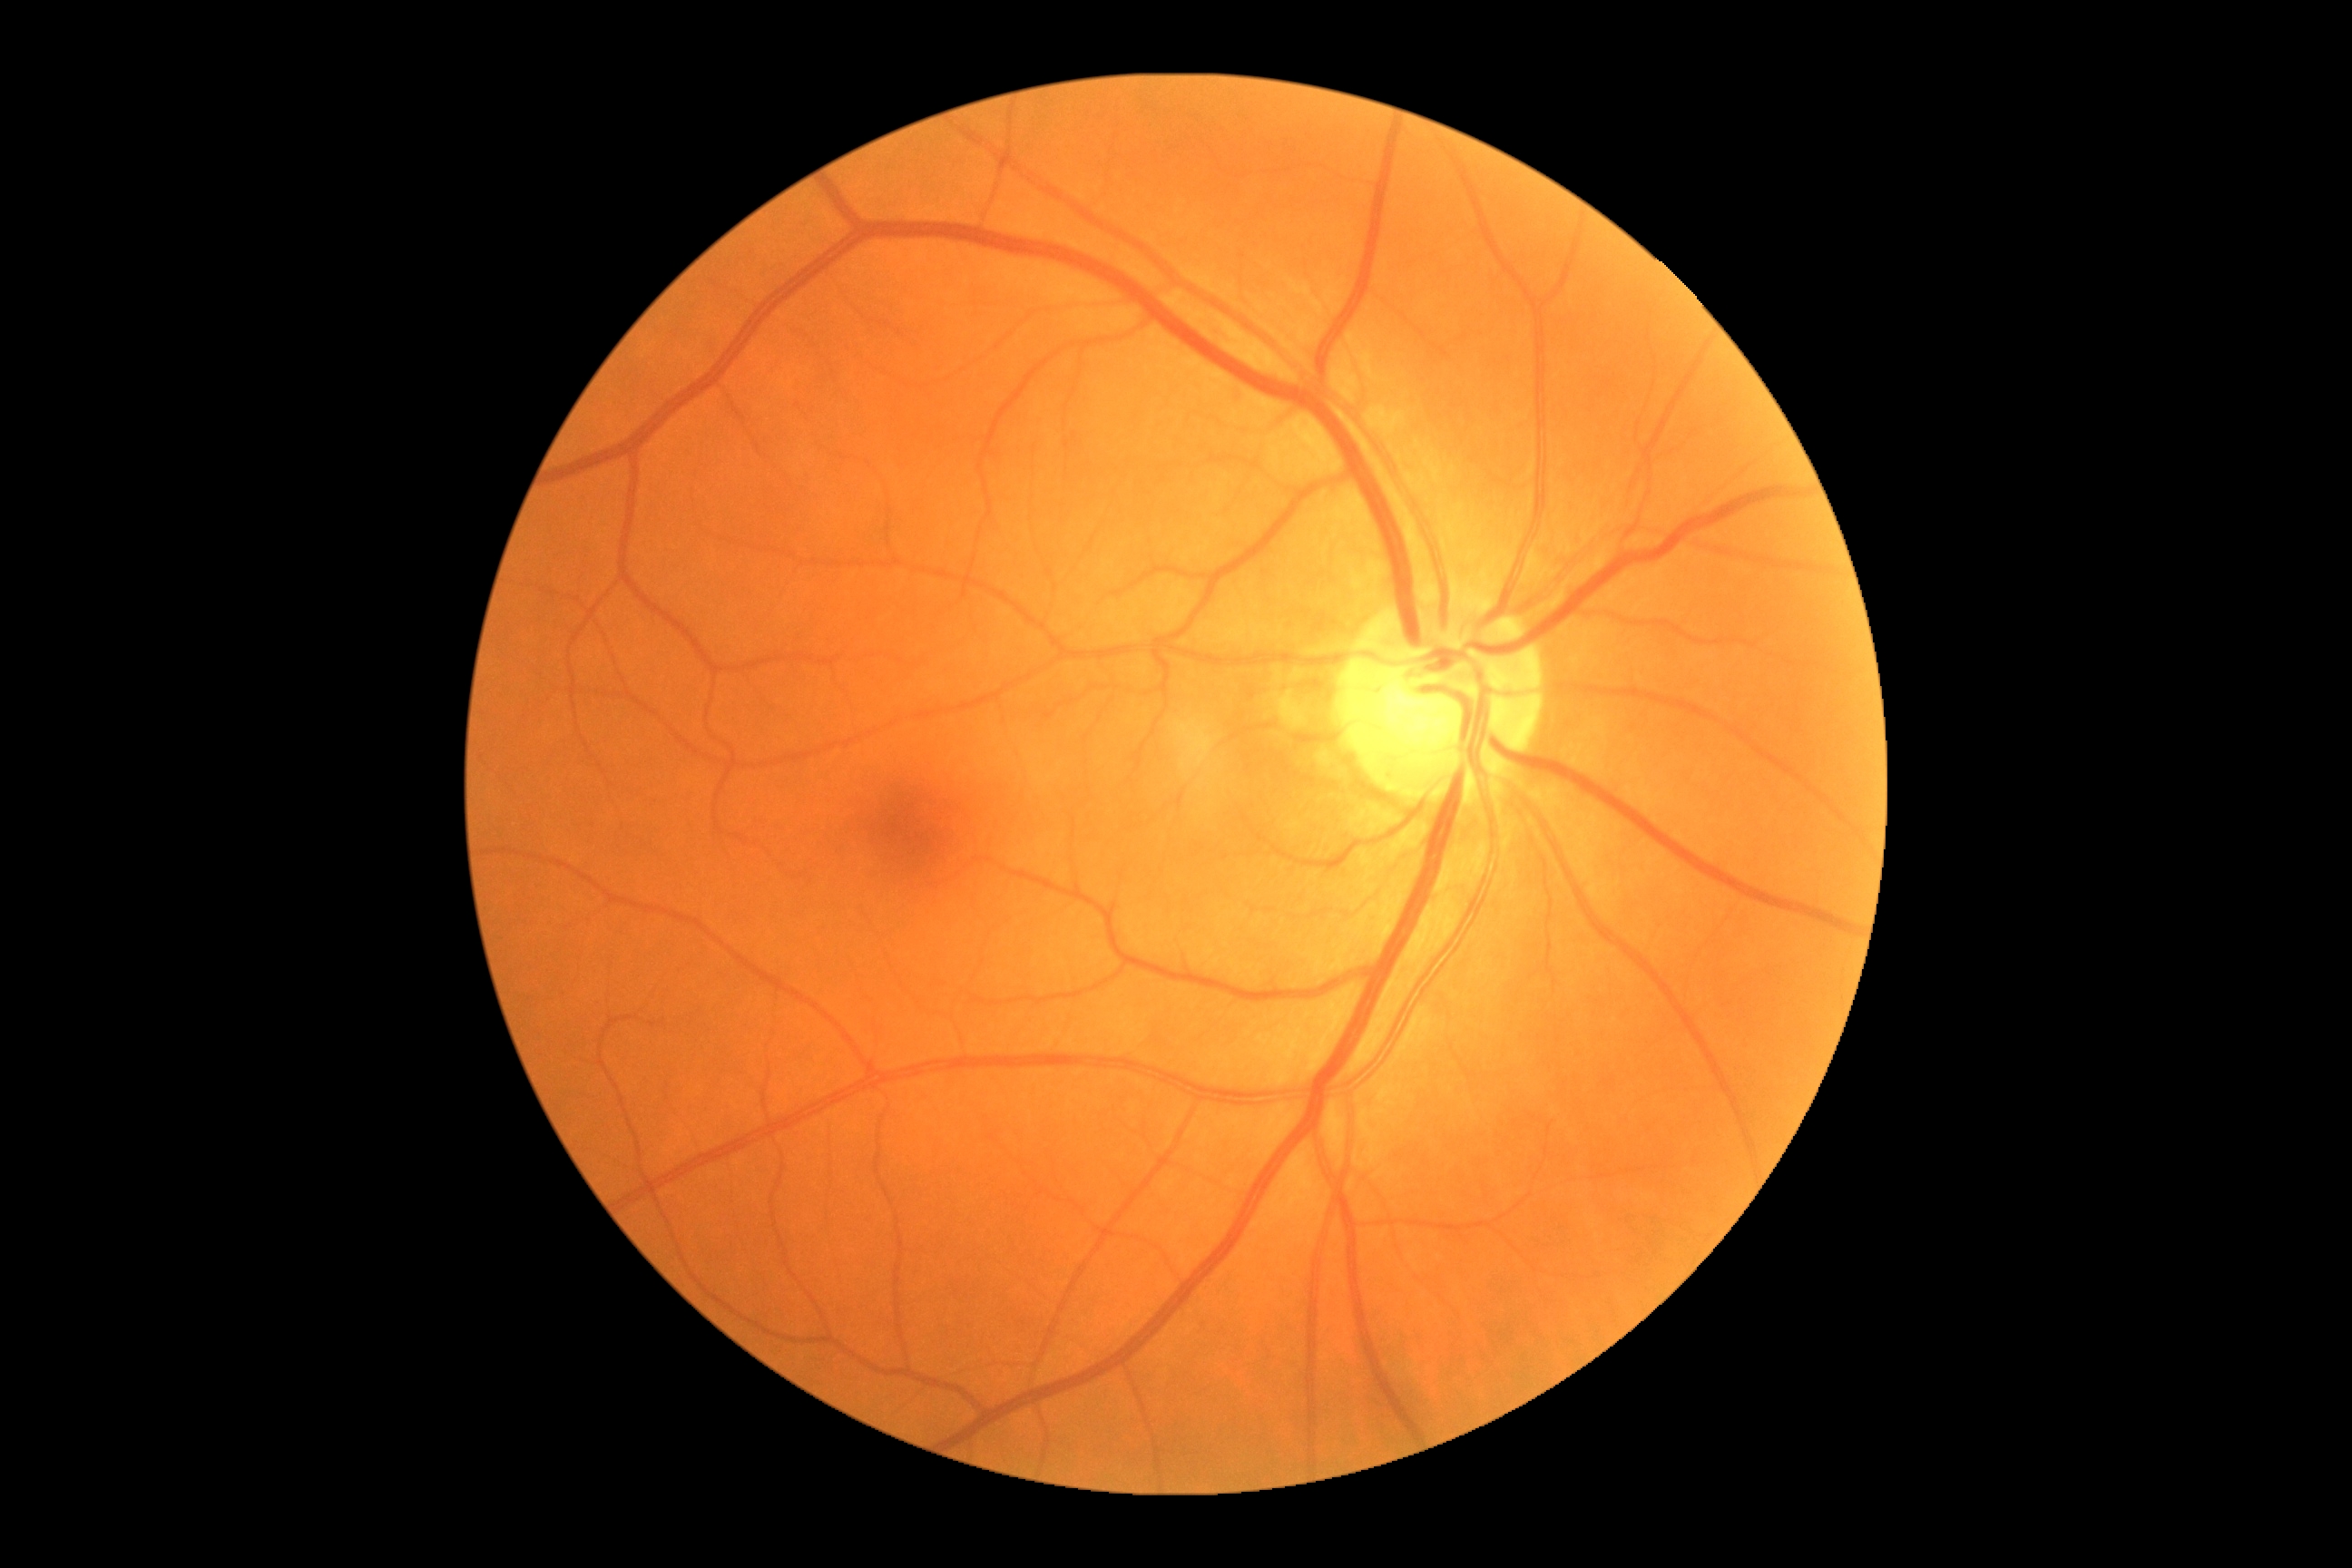

dr_grade: grade 0 (no apparent retinopathy) — no visible signs of diabetic retinopathy